Fundus photo; nonmydriatic; 848x848; NIDEK AFC-230; diabetic retinopathy graded by the modified Davis classification; 45 degree fundus photograph: 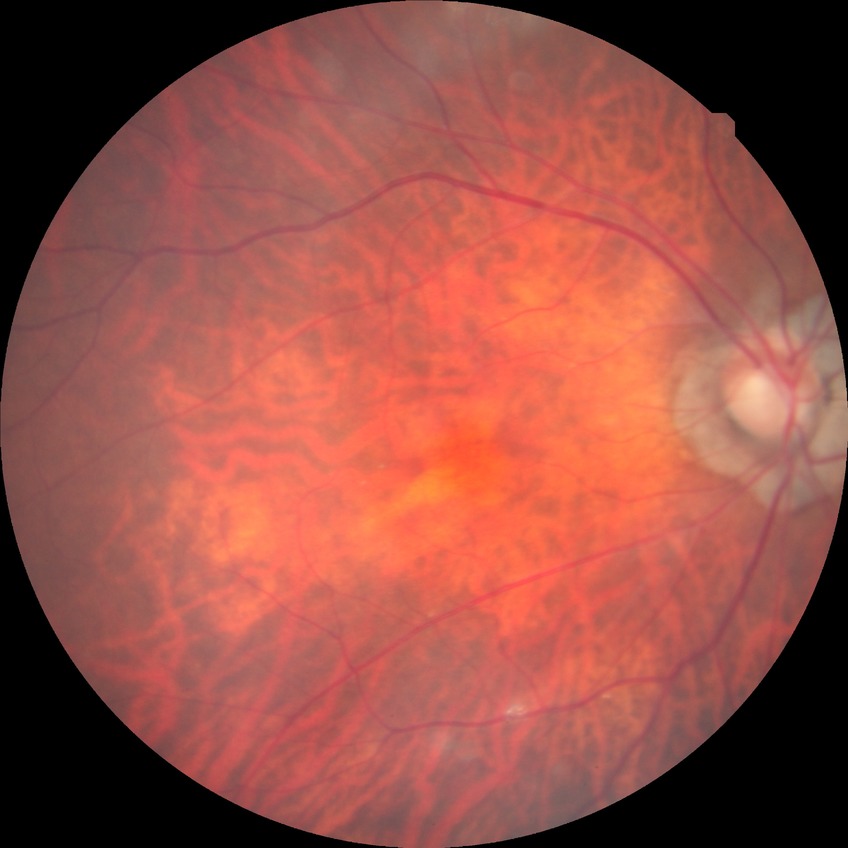
DR stage: NDR.